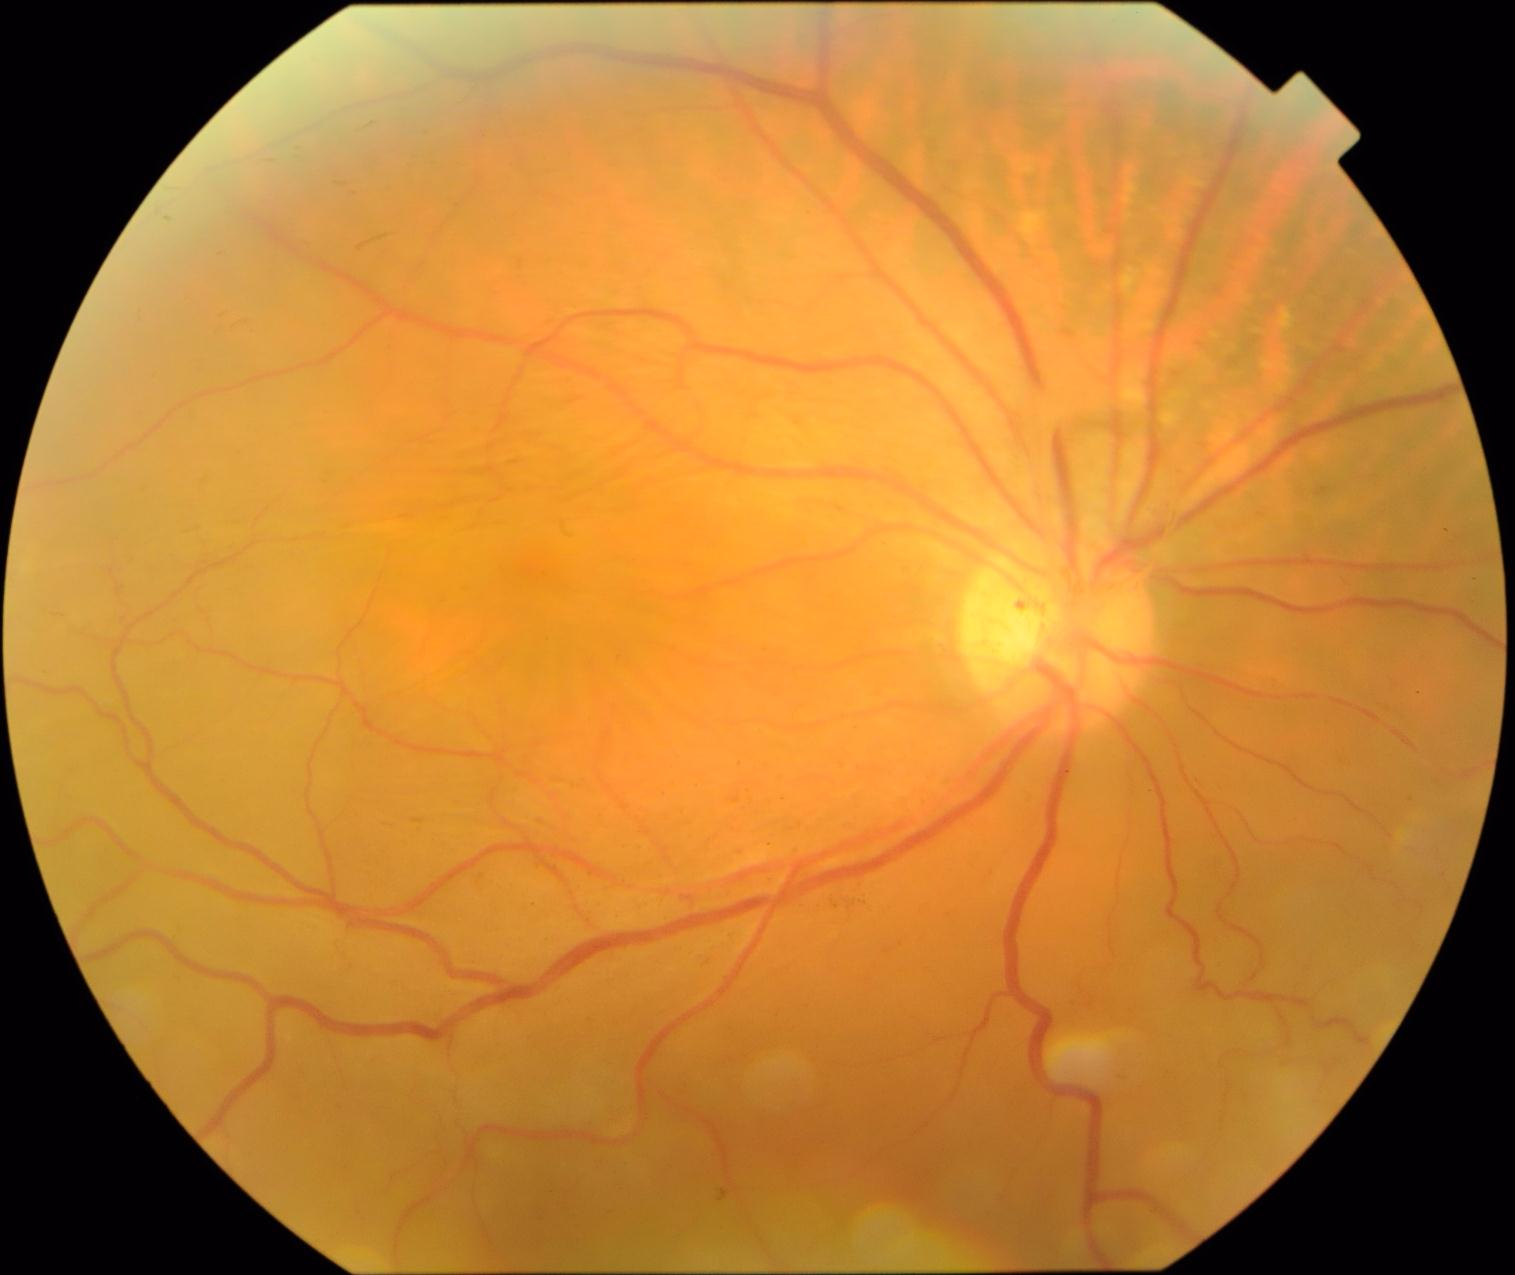
Diabetic retinopathy (DR) is PDR (grade 4).